Disc-centered fundus crop — 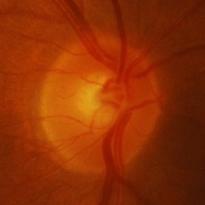 Glaucomatous changes are present.
Evidence of glaucoma.